Acquired with a NIDEK AFC-230, Davis DR grading:
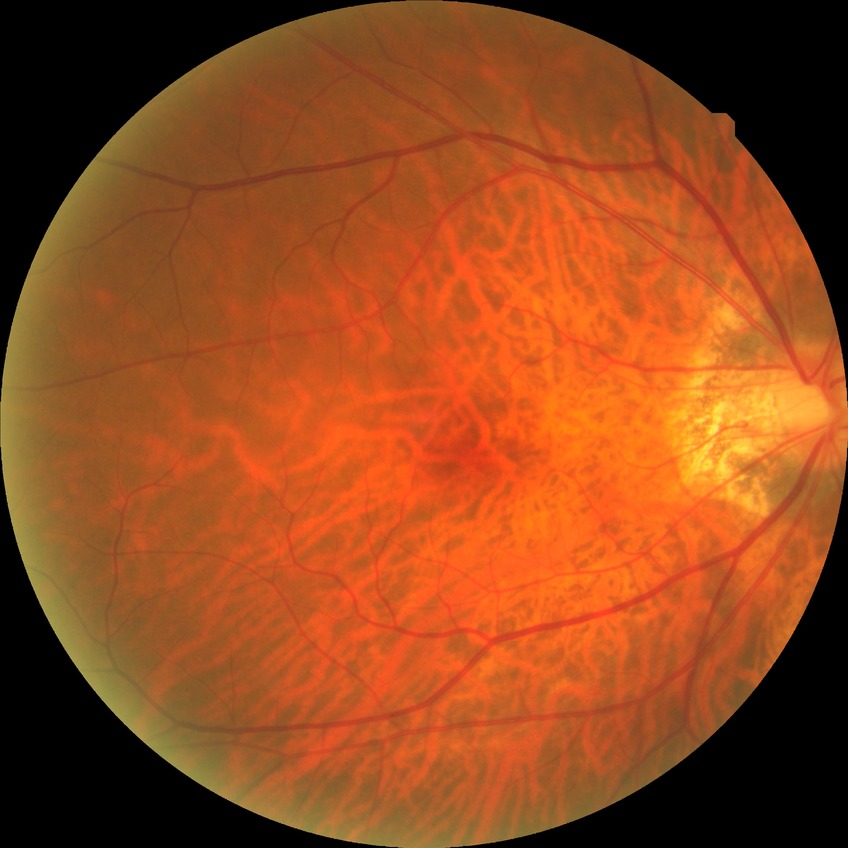

No apparent diabetic retinopathy. Modified Davis grade: NDR.